No pharmacologic dilation.
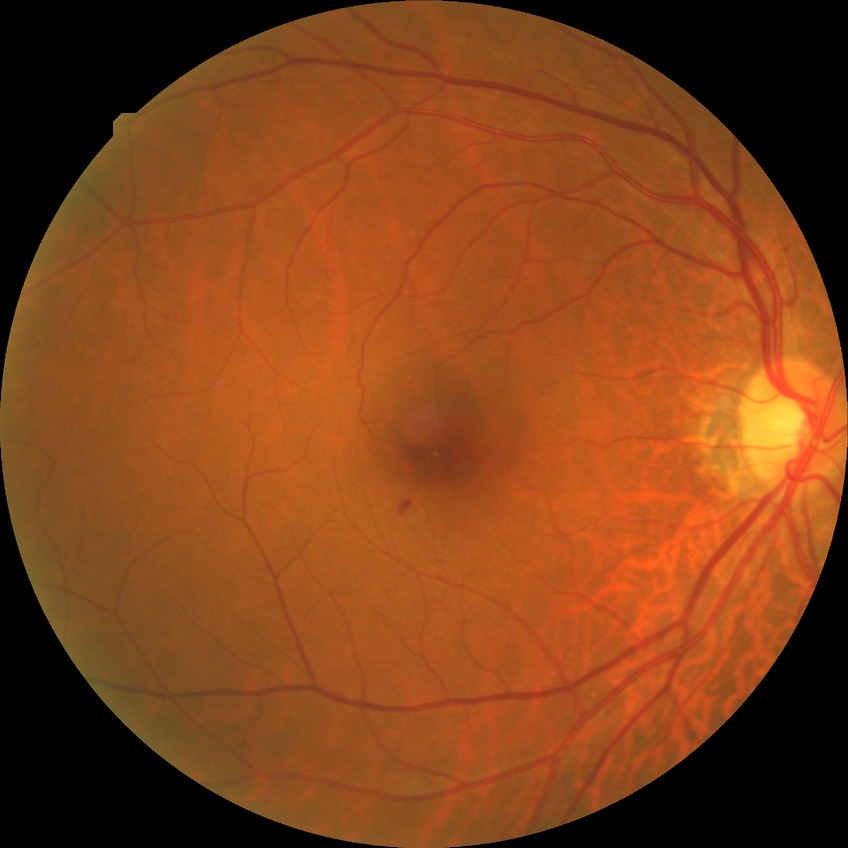 Diabetic retinopathy (DR): no diabetic retinopathy (NDR).